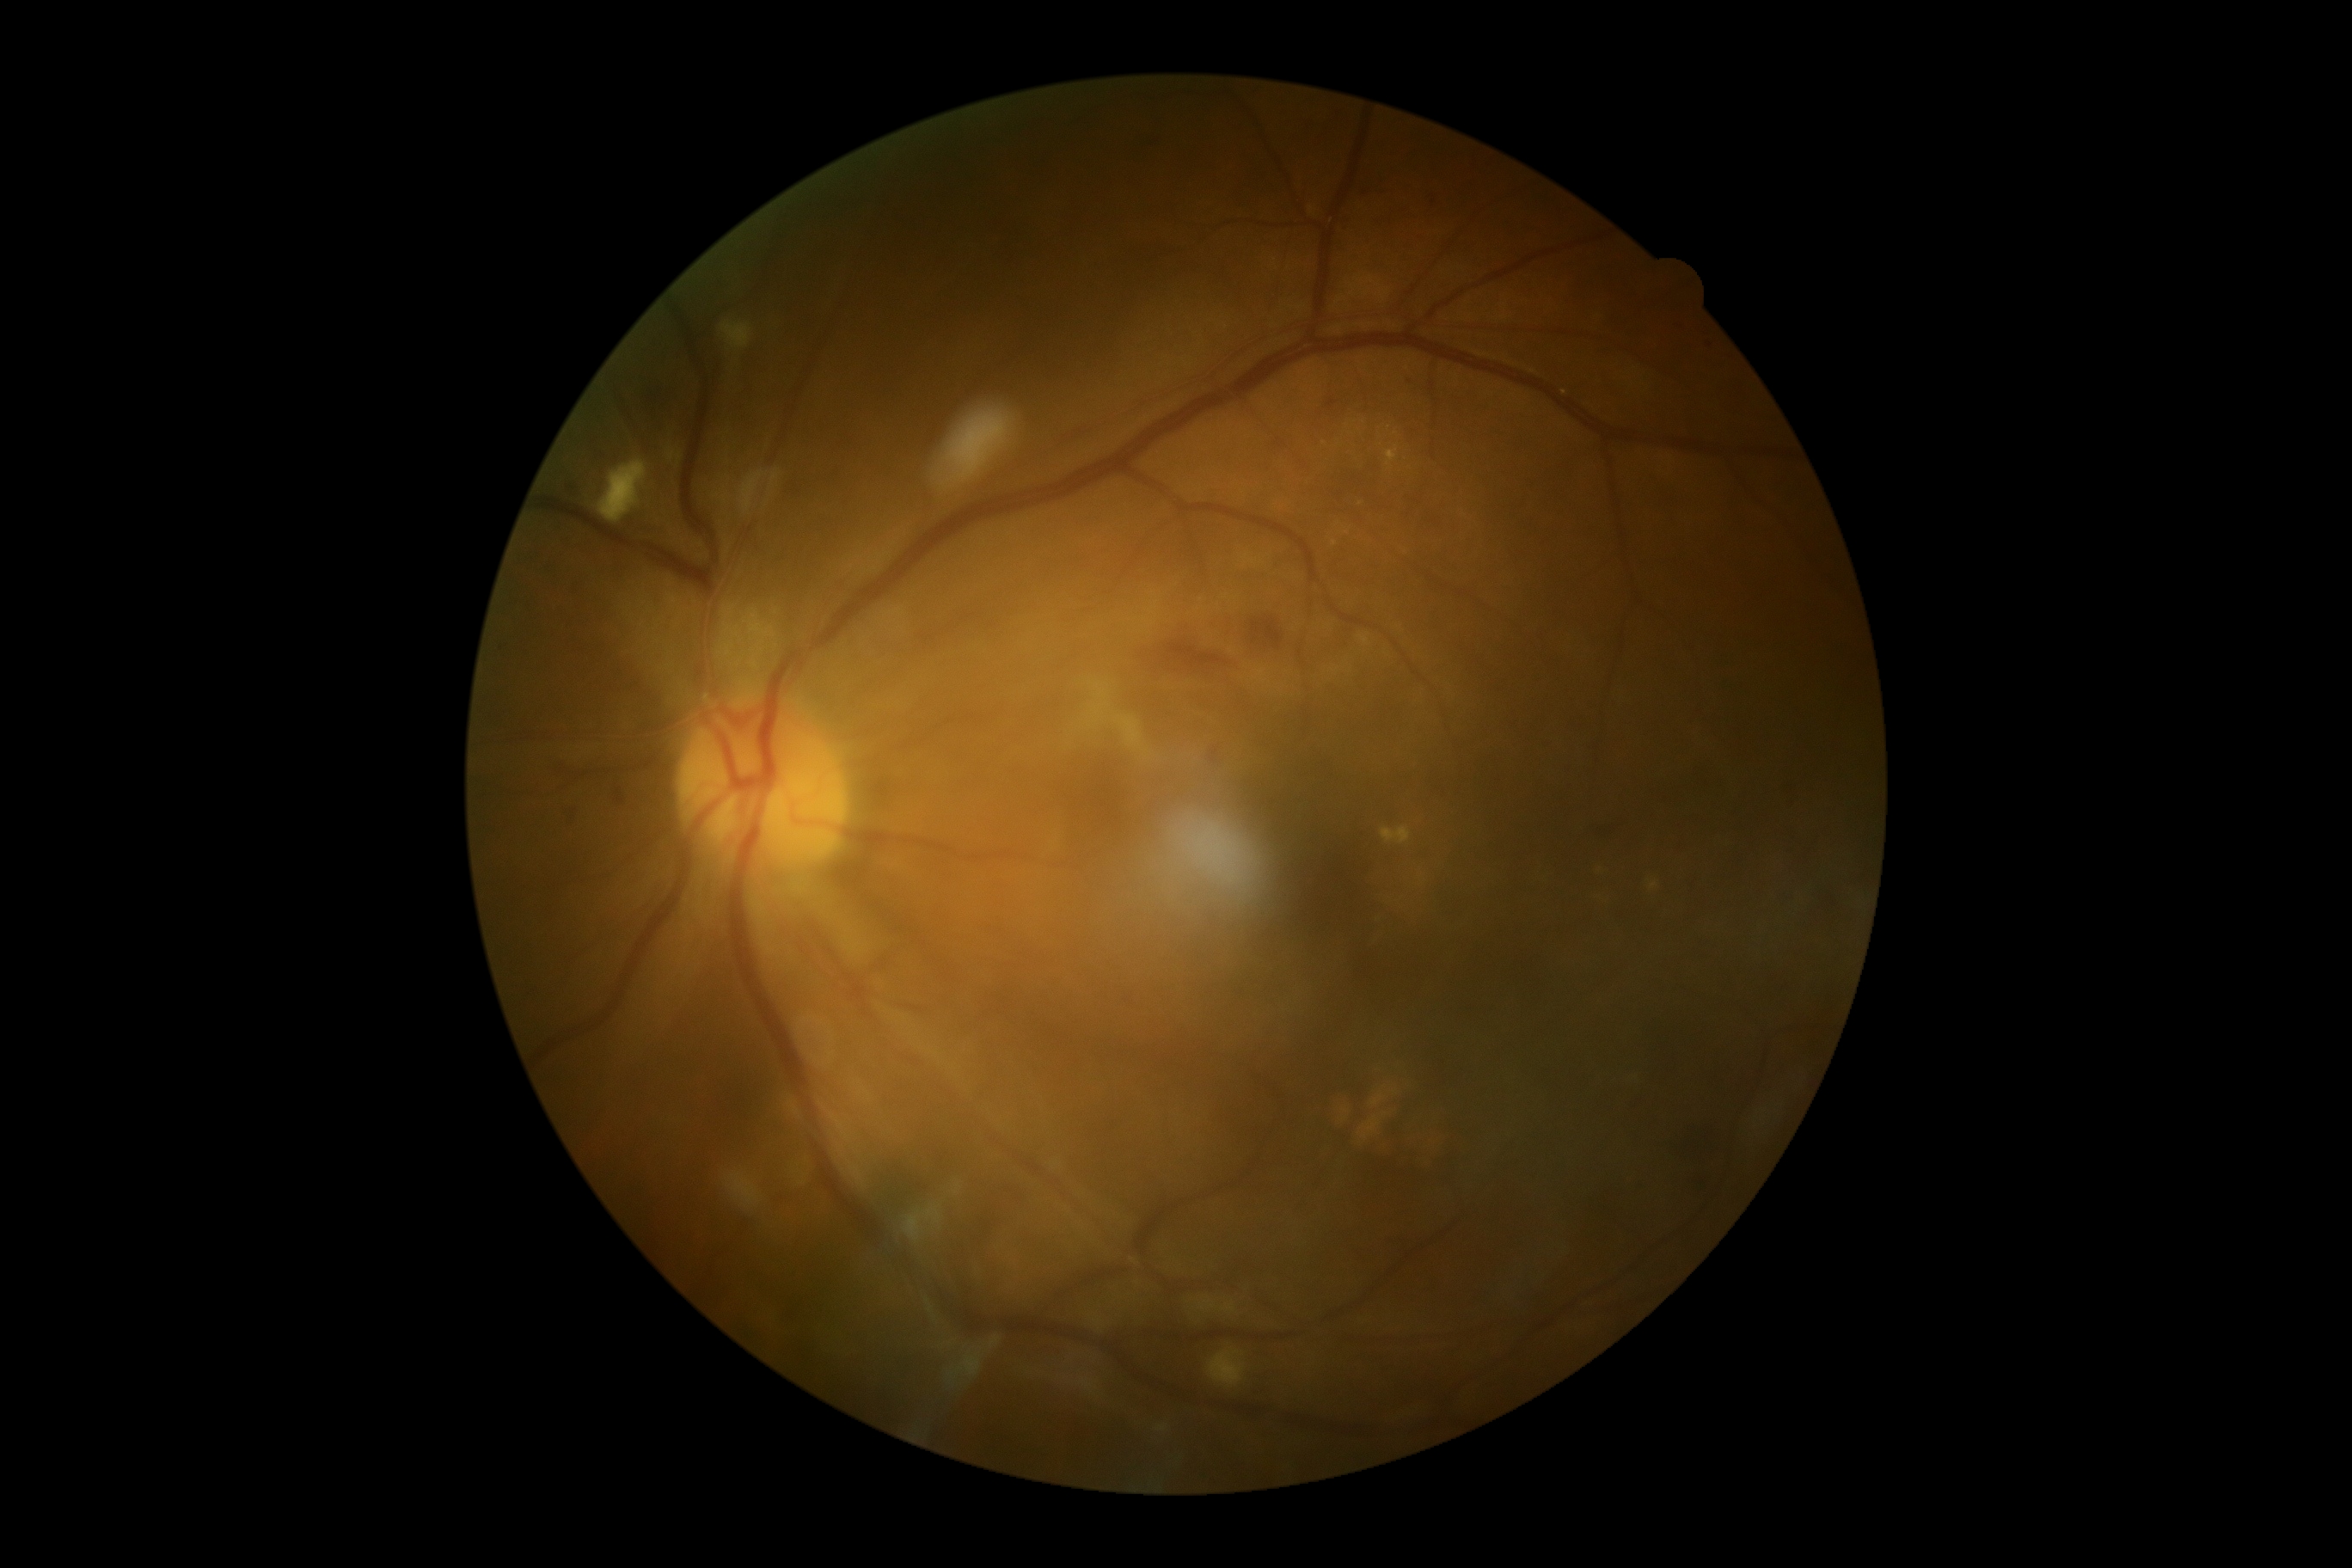
dr_grade: 2/4 — more than just microaneurysms but less than severe NPDR